Color fundus photograph
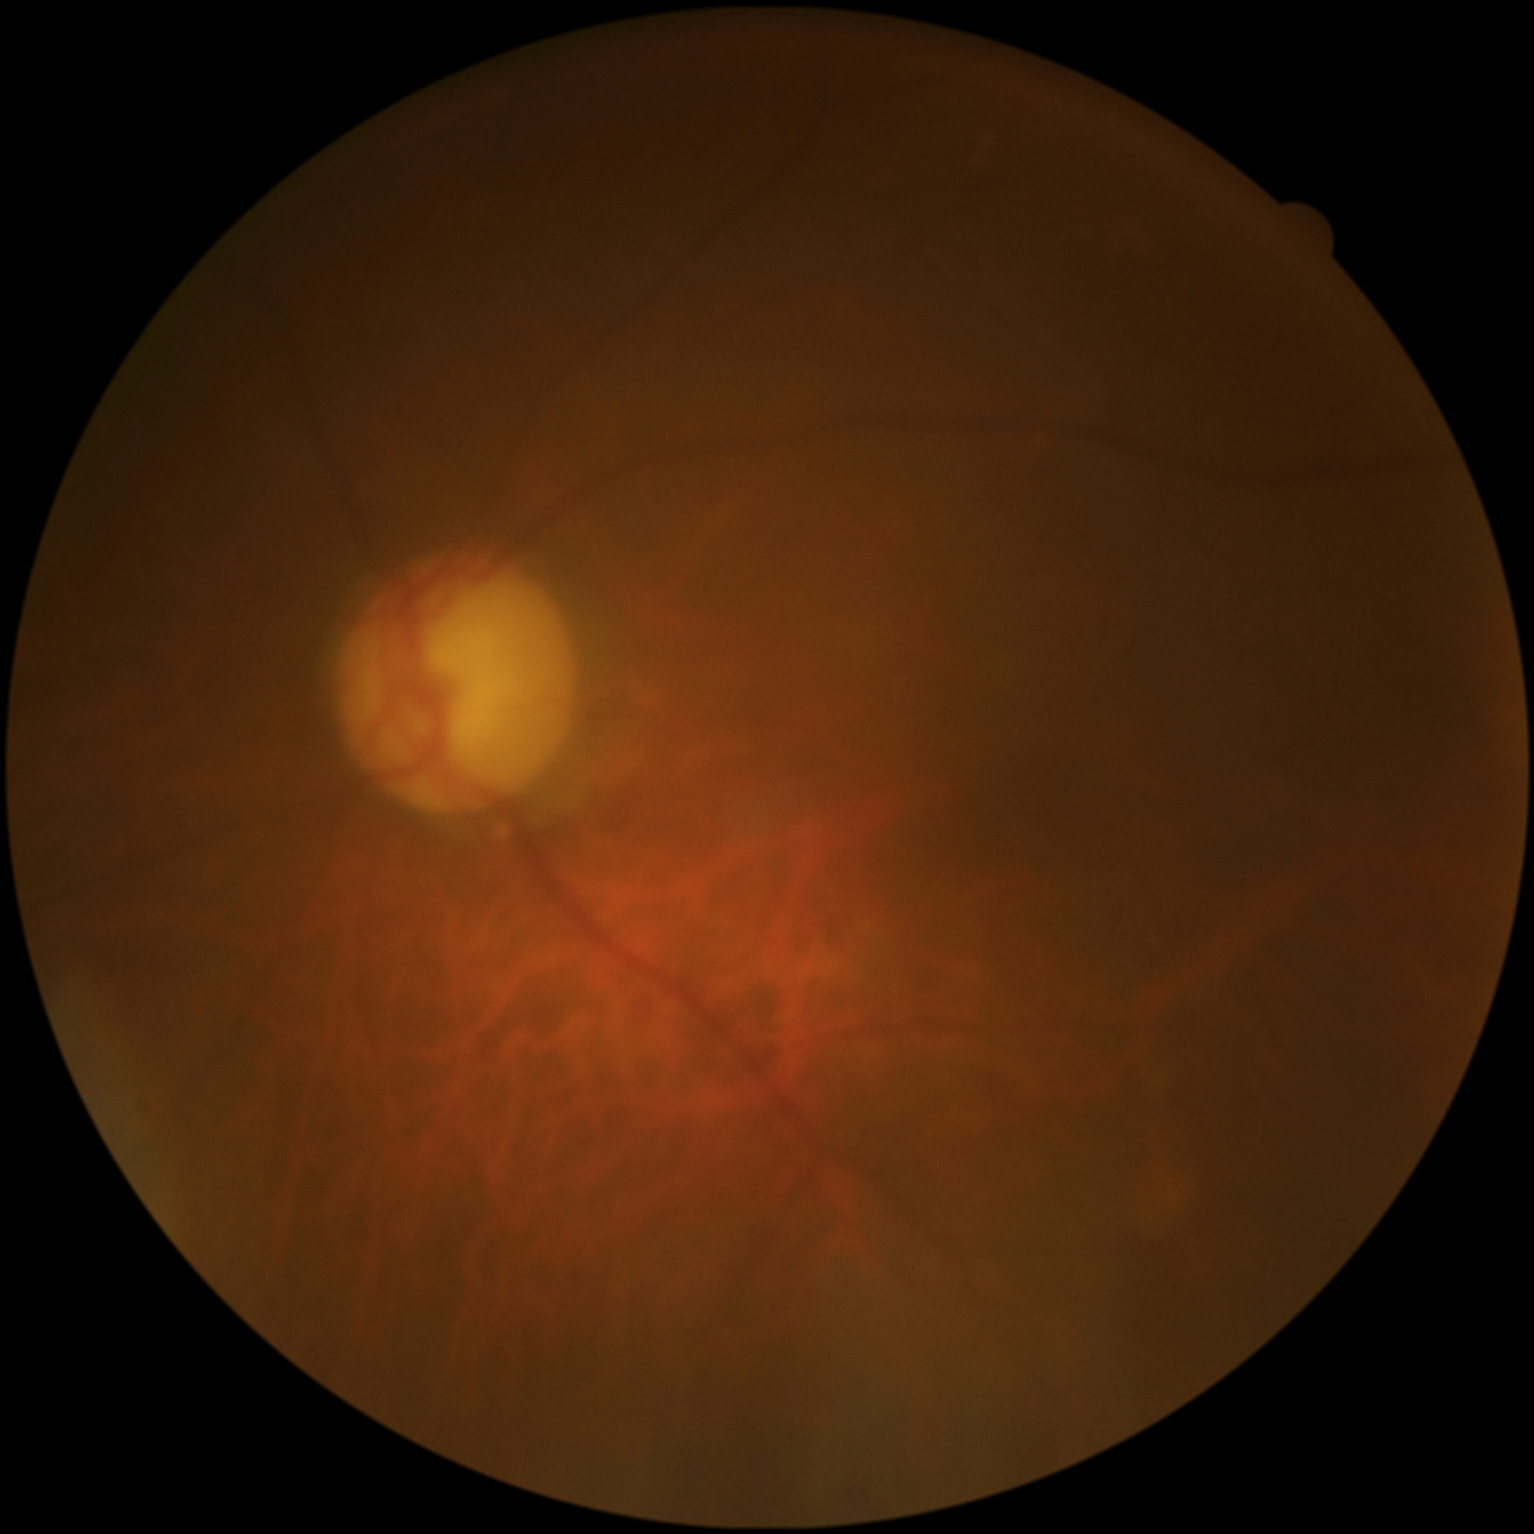
The image is blurry.
Overall quality is poor; the image is difficult to grade.
Vessels and details are hard to distinguish.
Illumination and color are suboptimal.